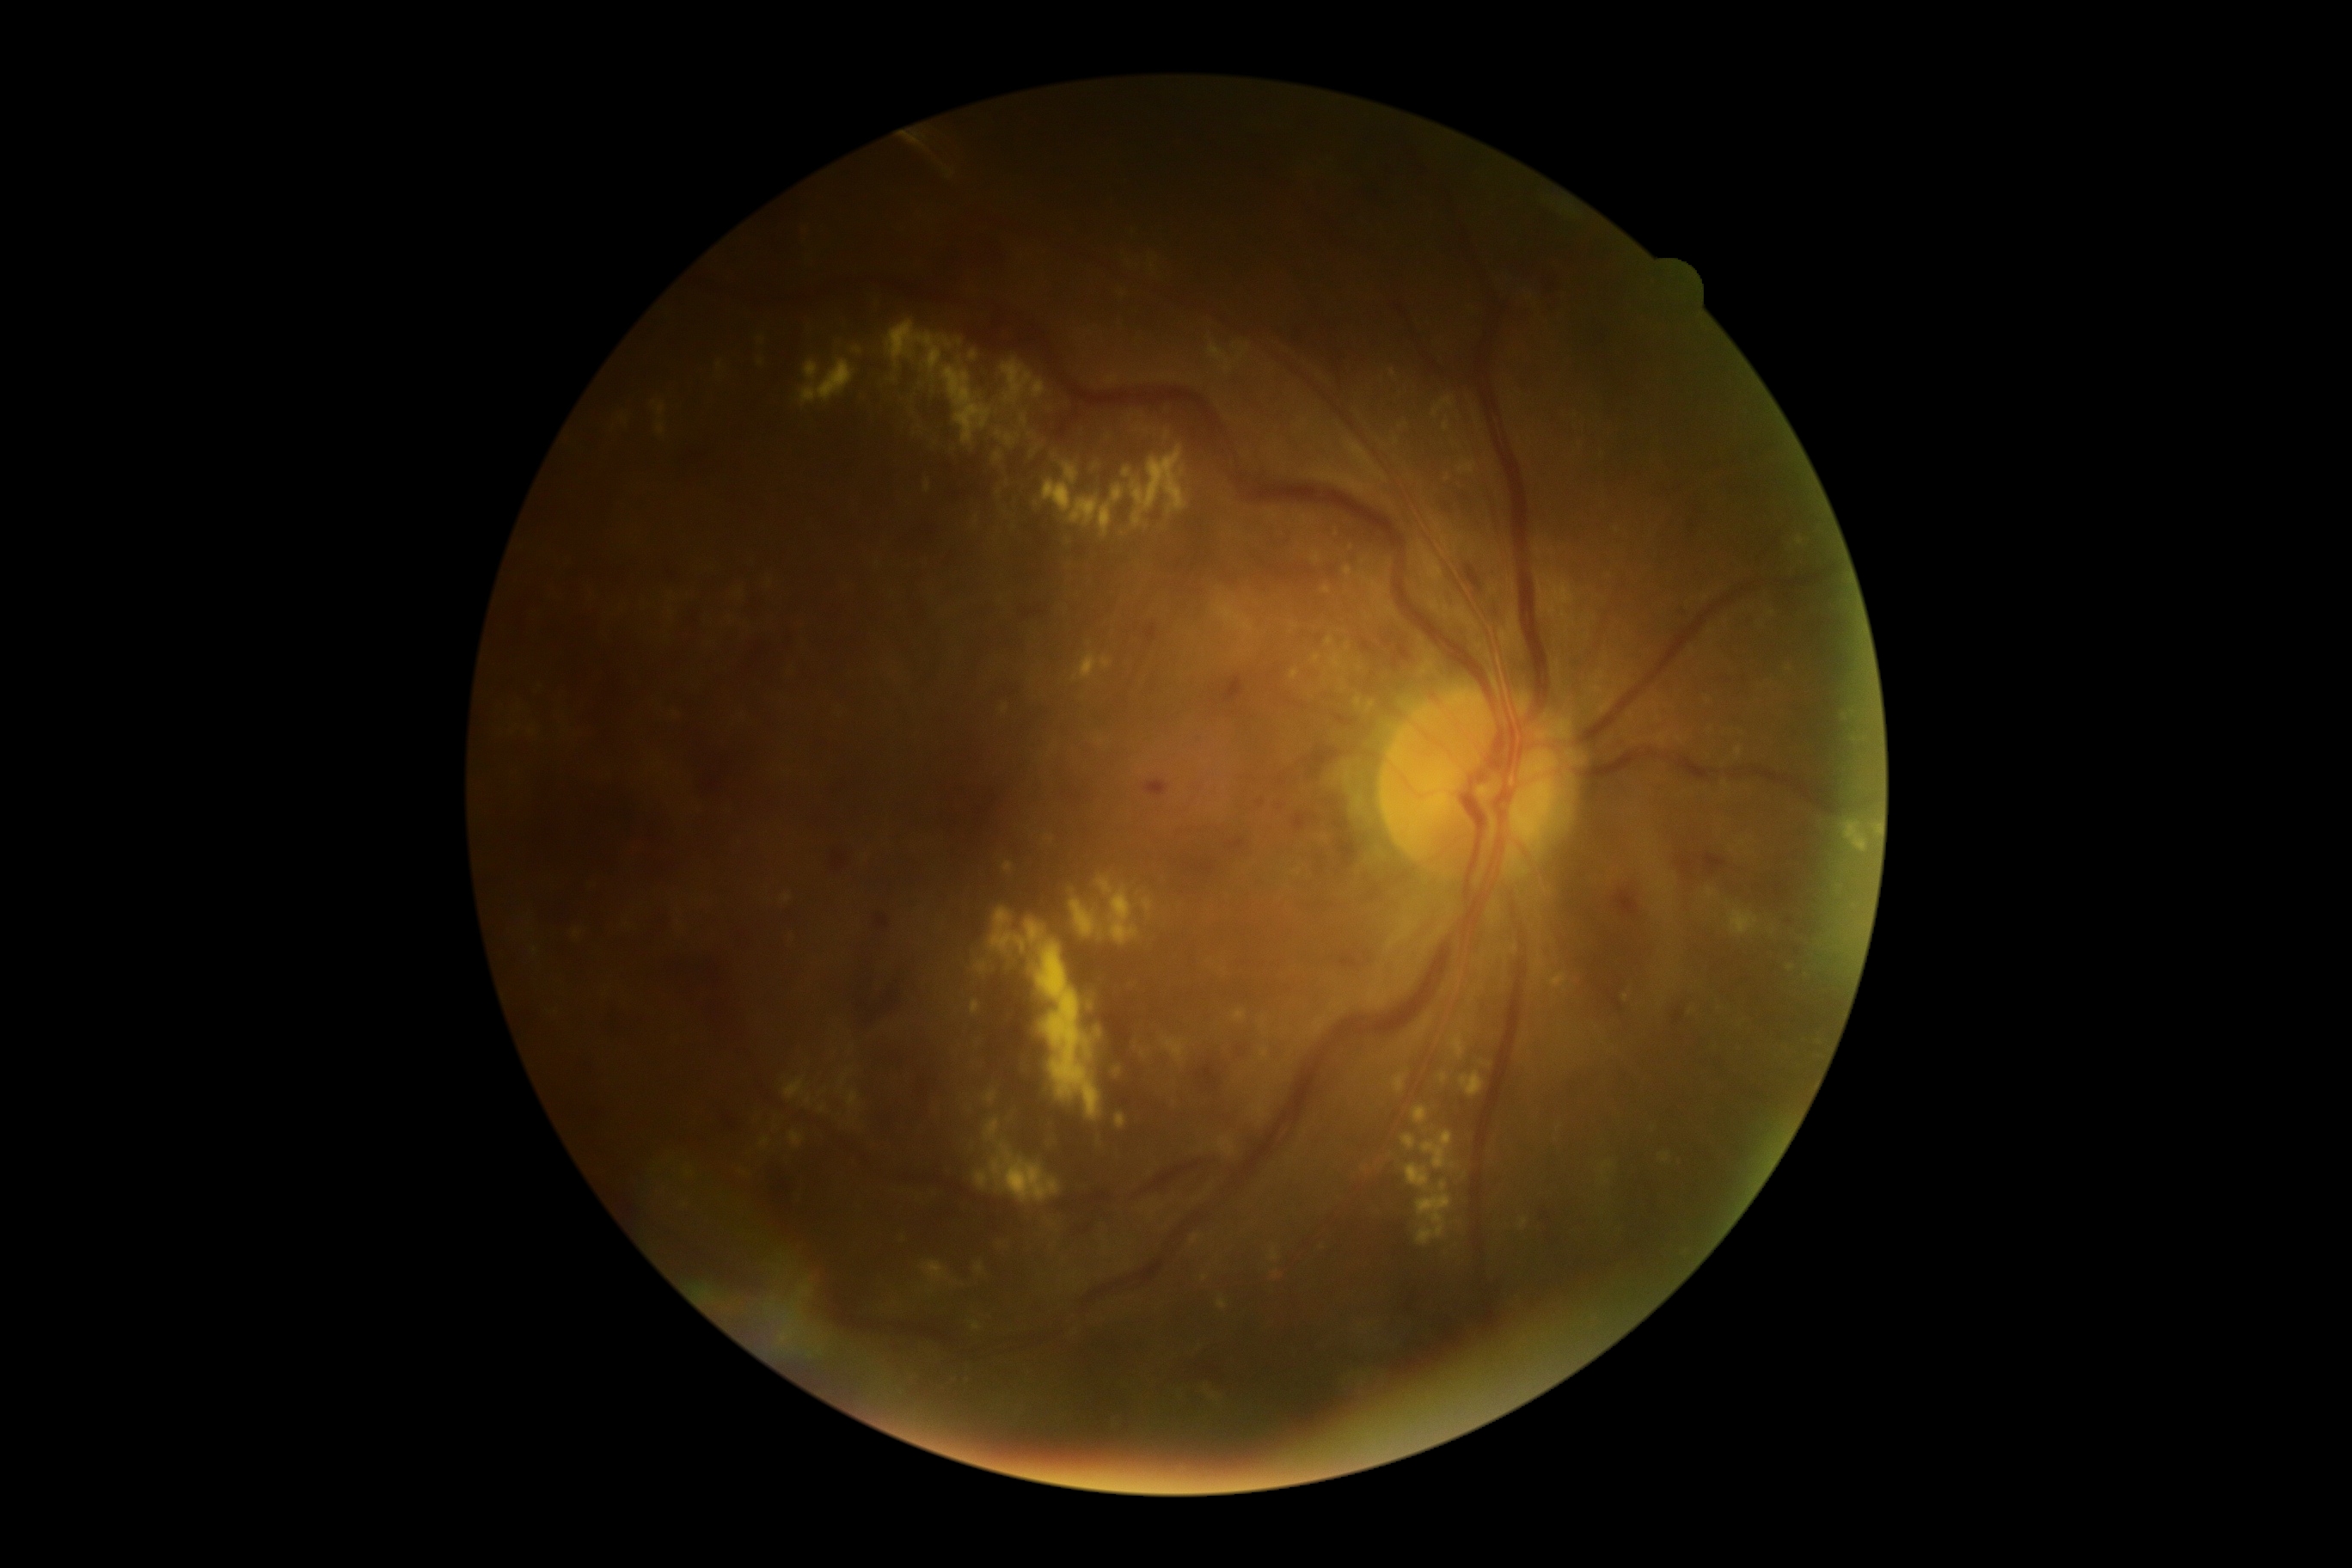

Diabetic retinopathy (DR) is 3.